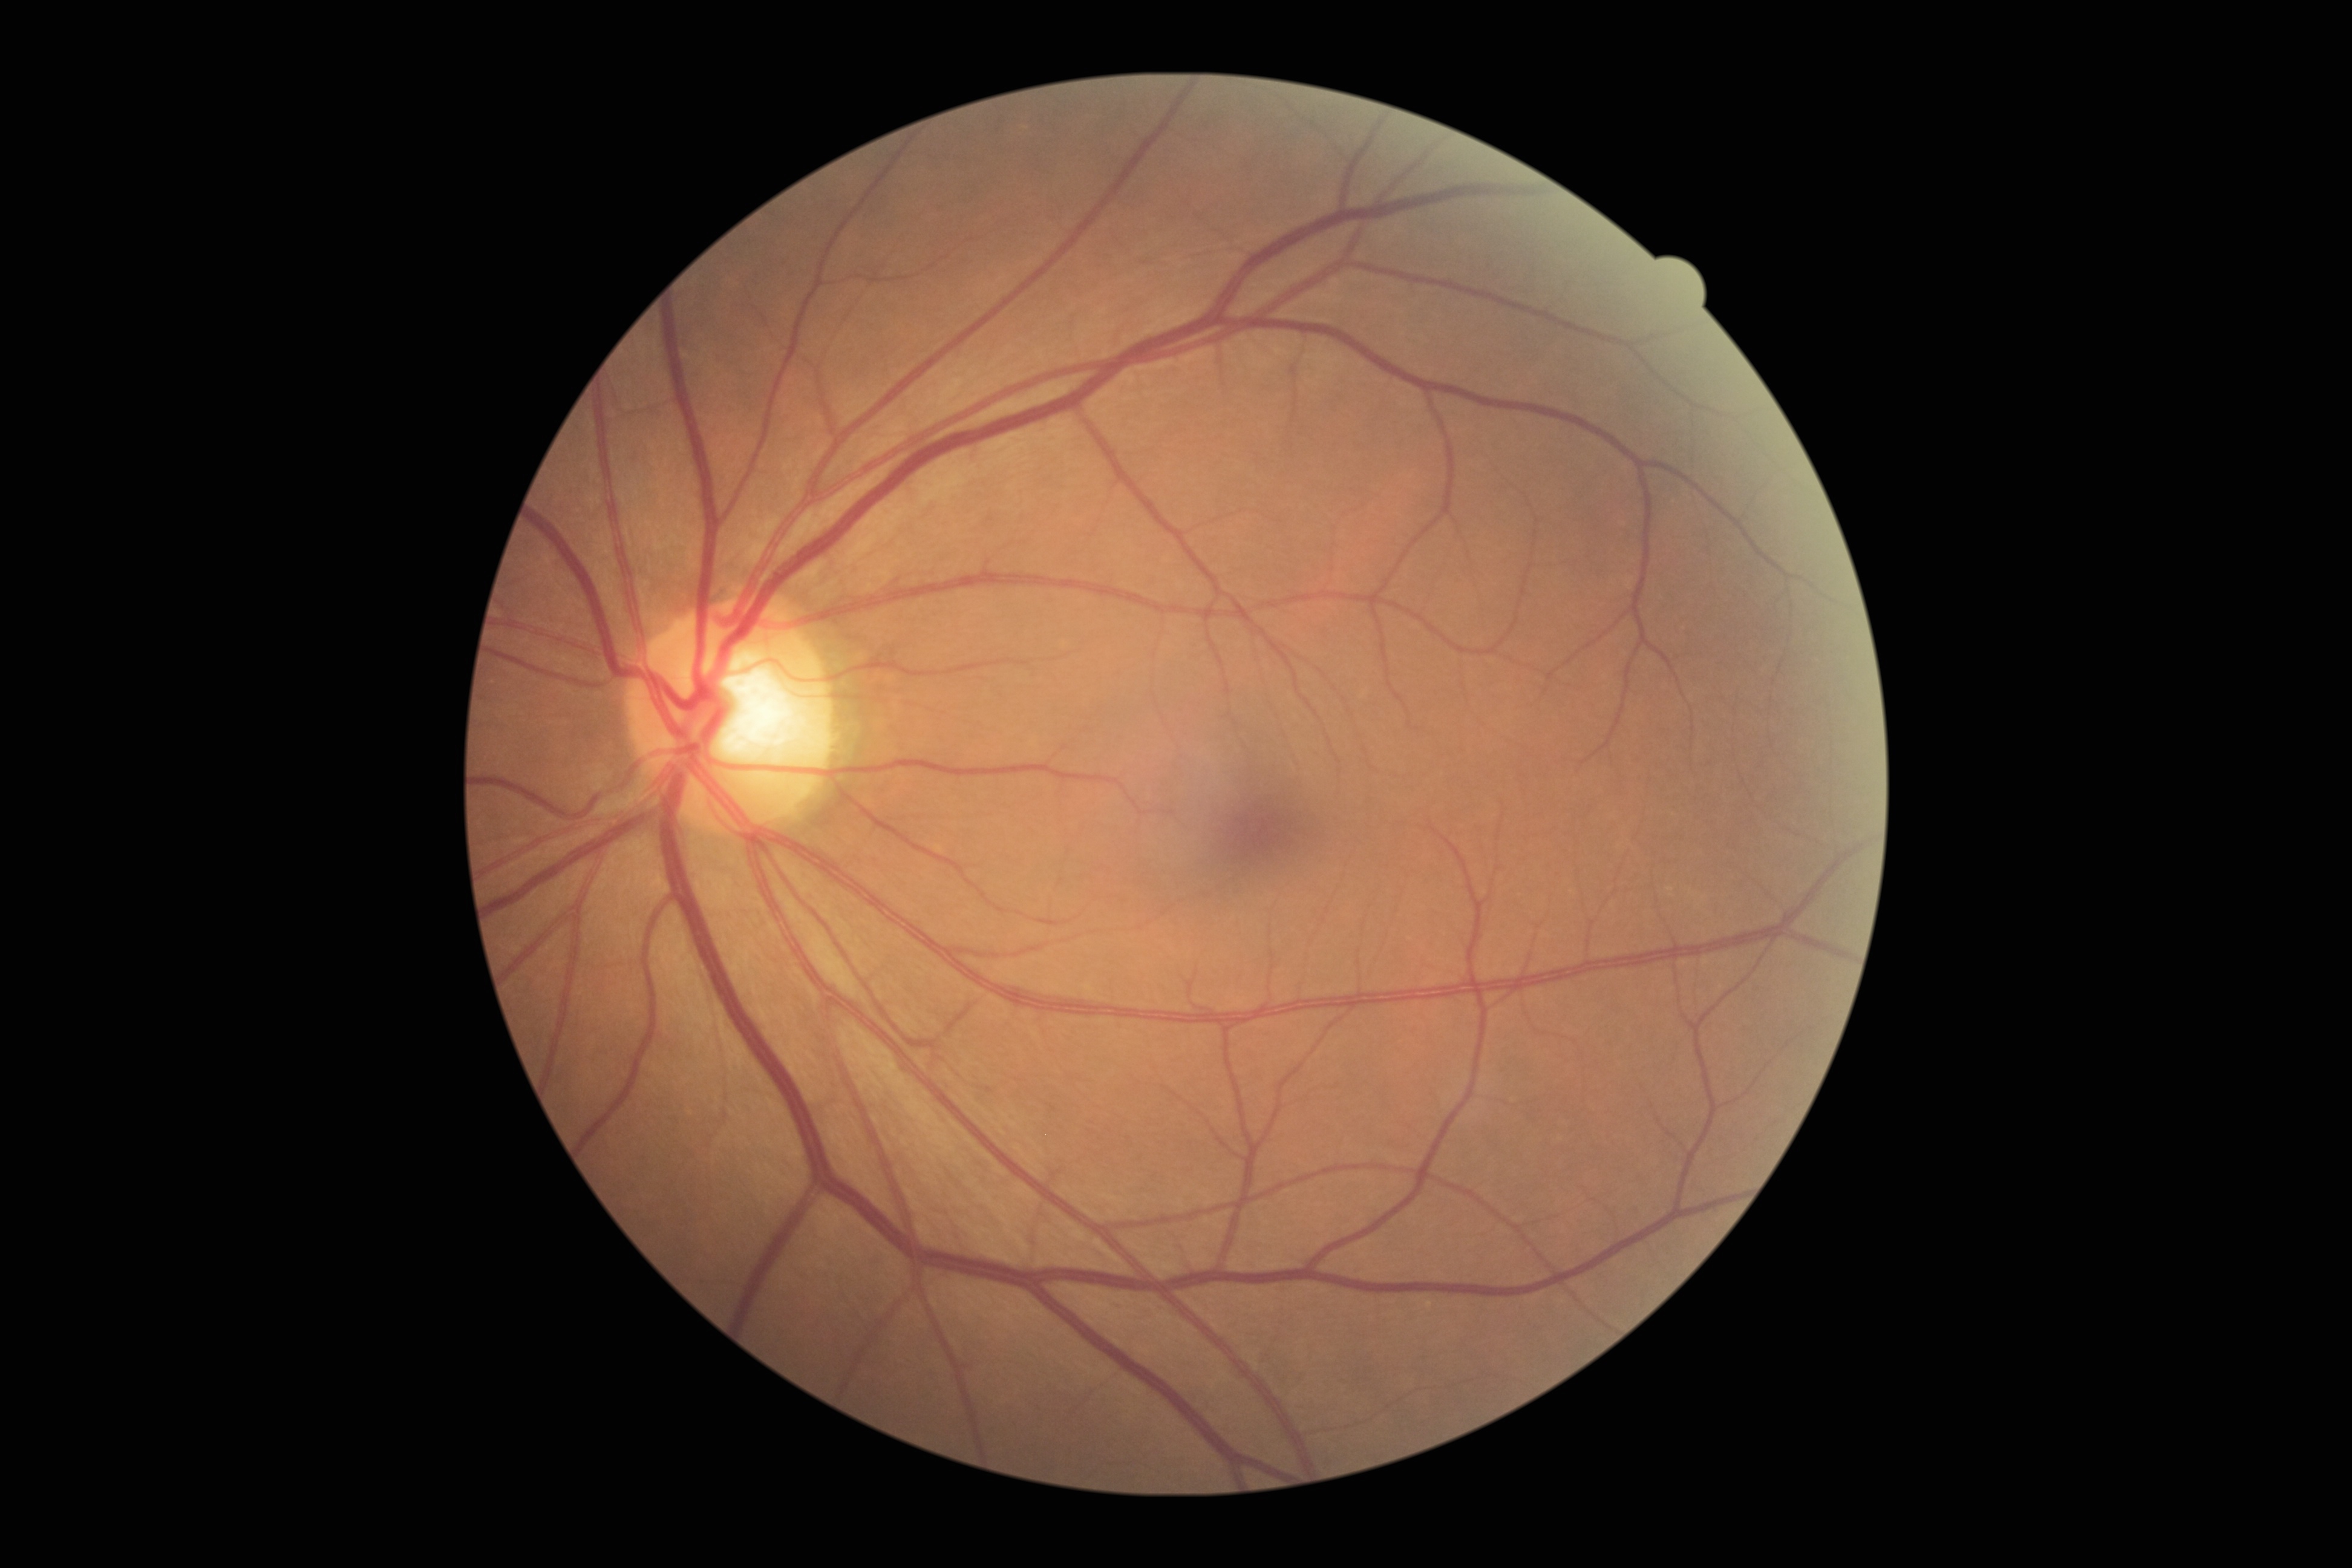
{"dr_grade": "grade 0 (no apparent retinopathy) — no visible signs of diabetic retinopathy"}